Acquired with a Nidek AFC-330 — 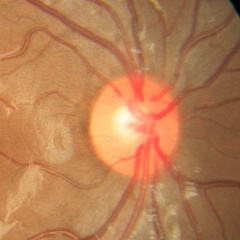
Q: Does this eye have glaucoma?
A: No — no glaucomatous changes.